Captured with the Phoenix ICON (100° field of view). Infant wide-field retinal image — 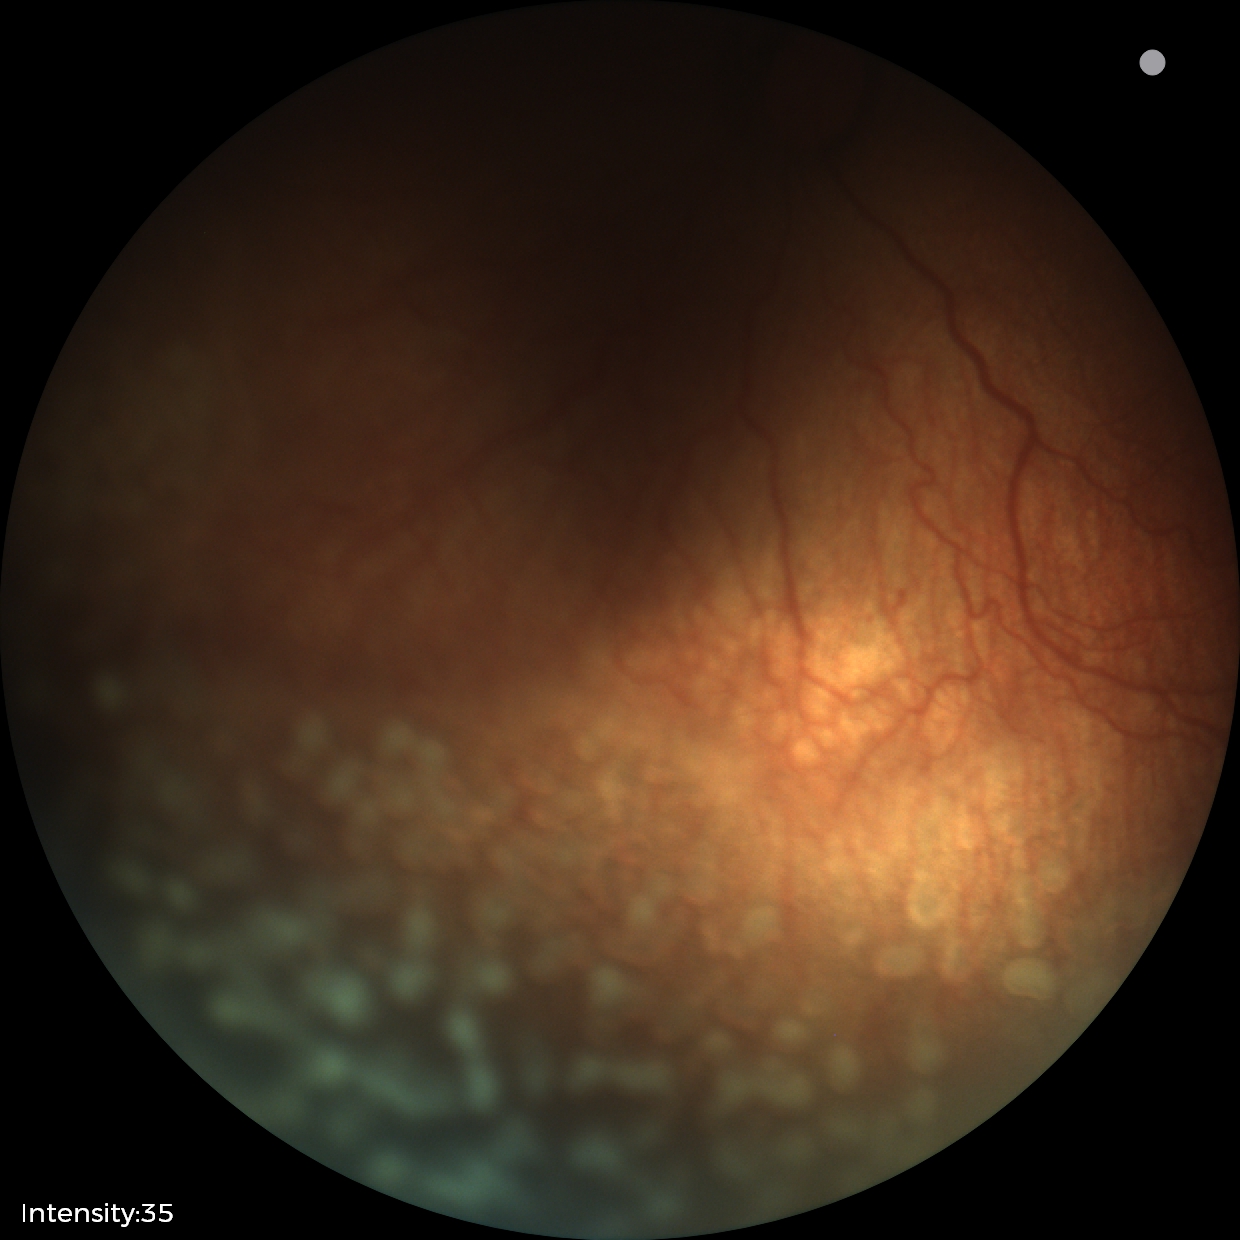
Screening examination consistent with ROP stage 2. Plus disease present.